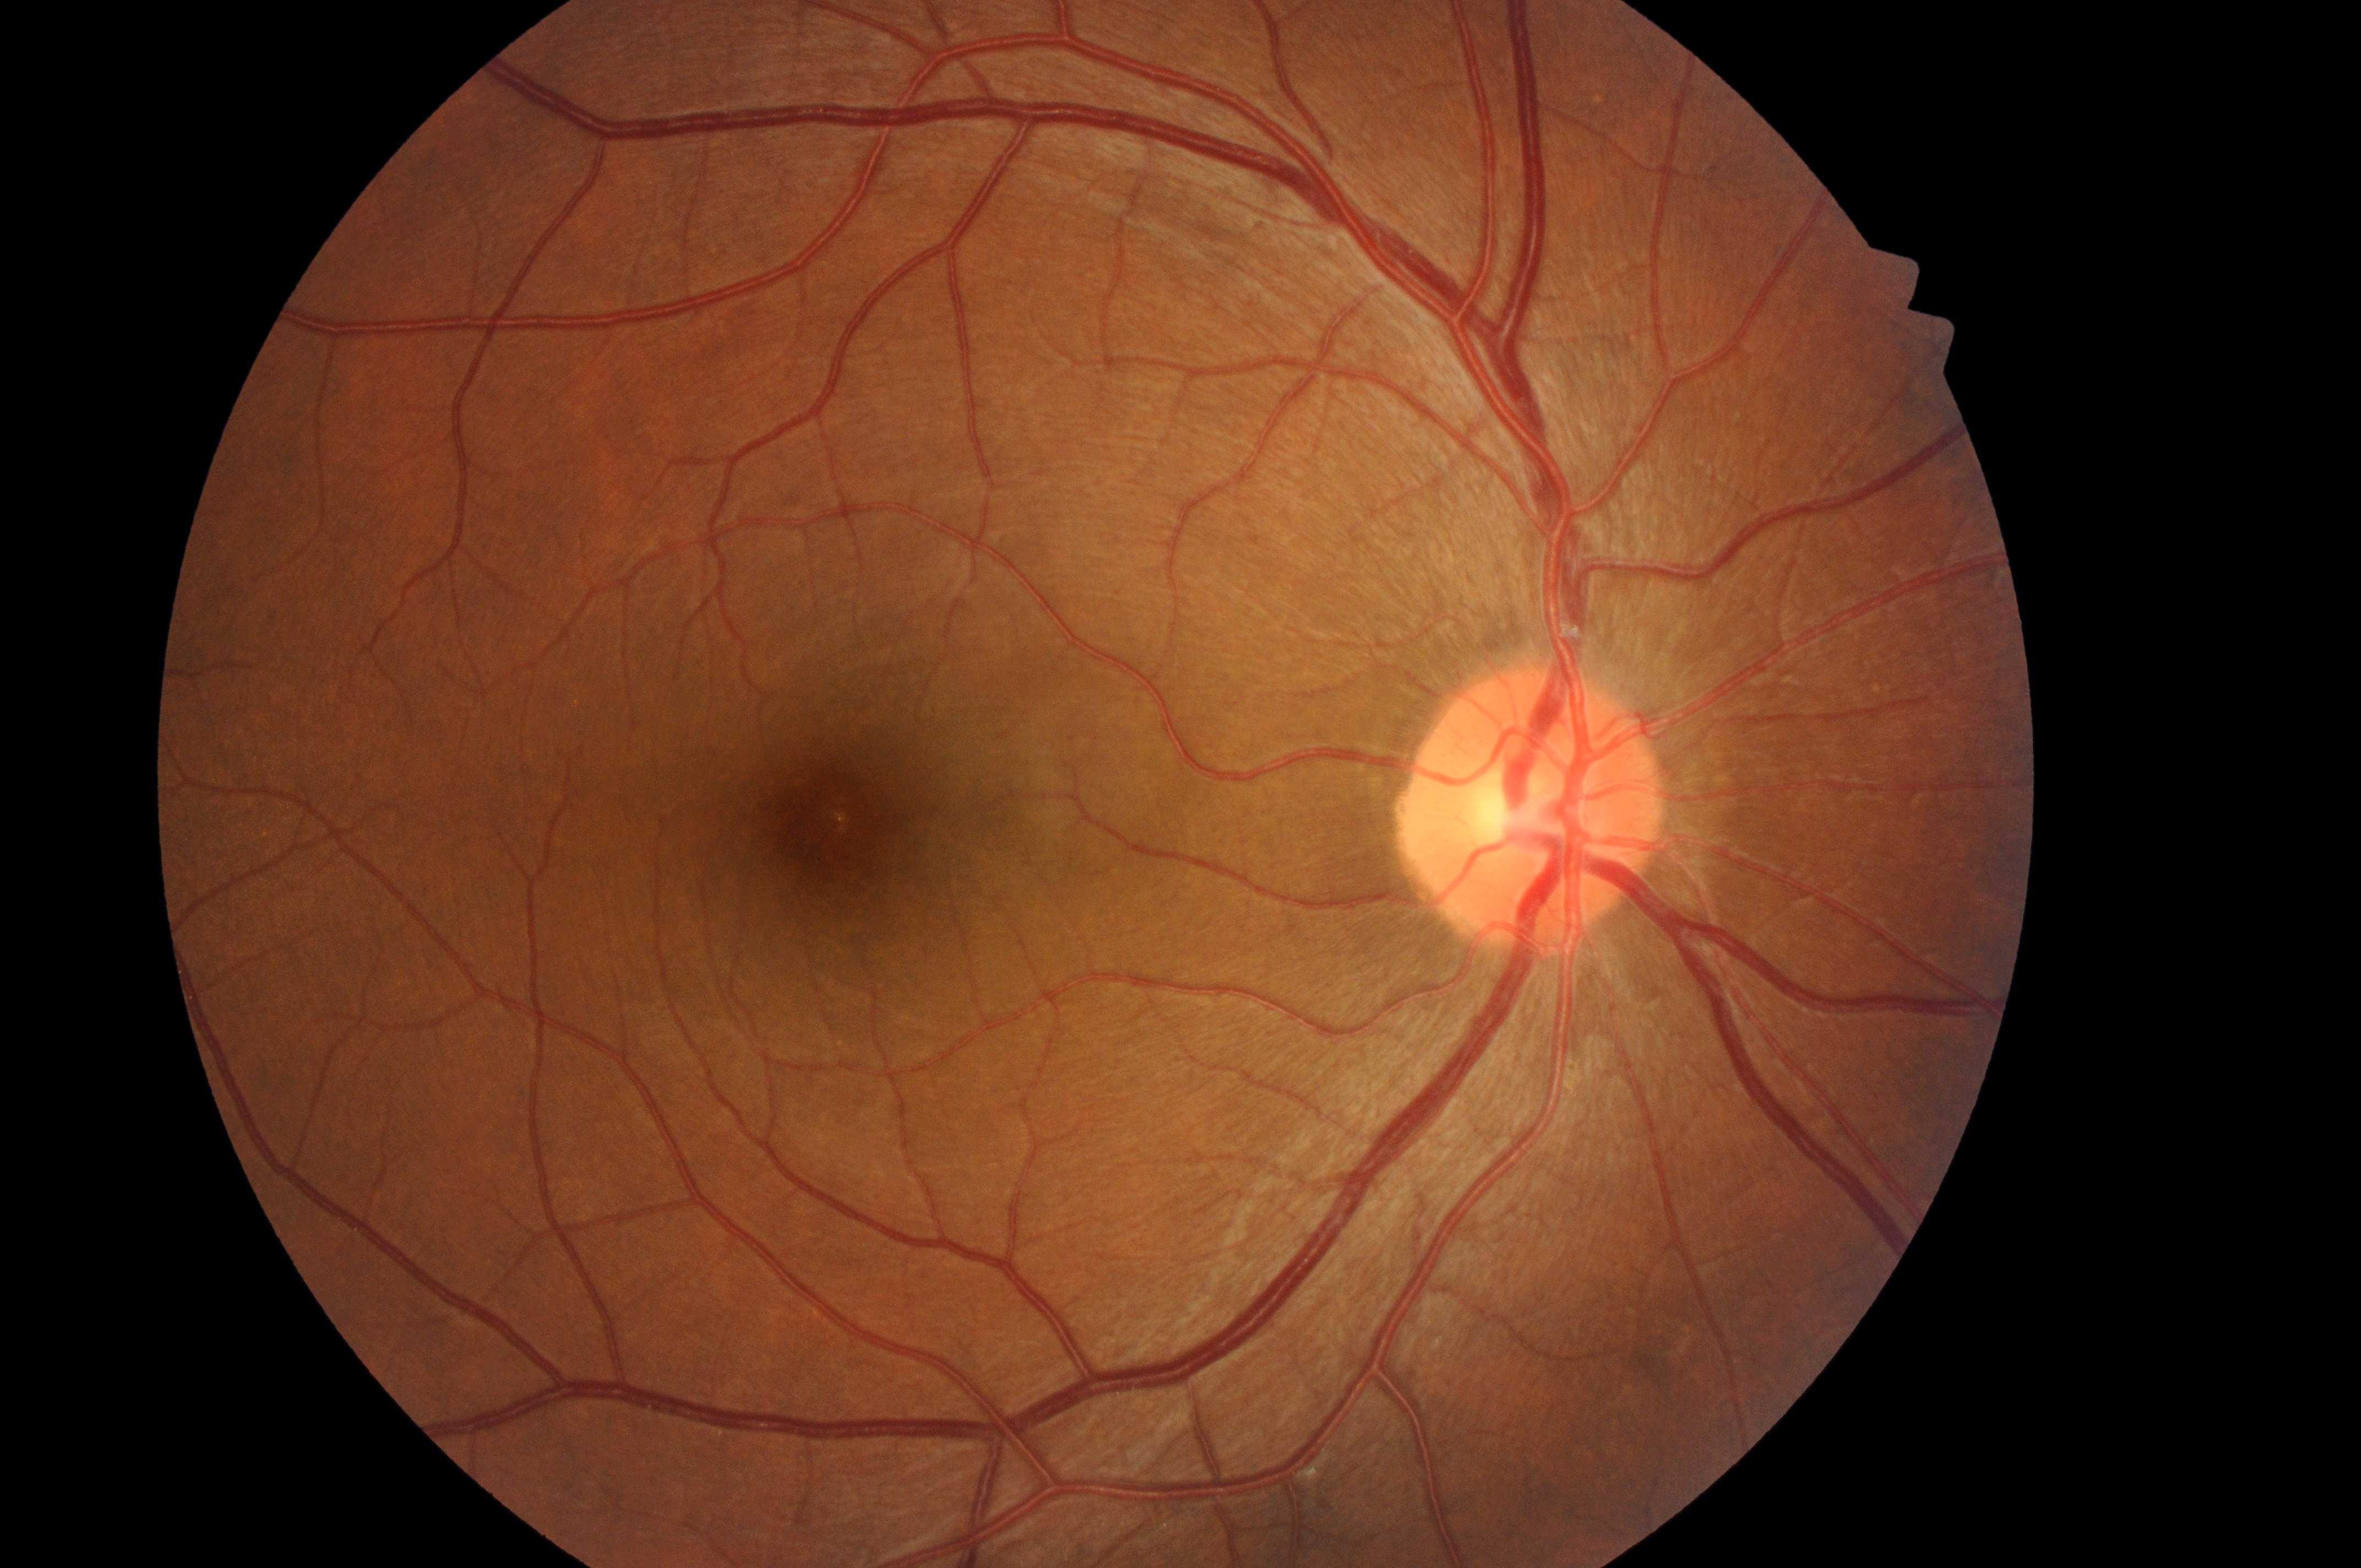

Optic disc: 1528, 814. Fovea centralis: 833, 826. Risk of diabetic macular edema: grade 0 (no risk). No signs of diabetic retinopathy or diabetic macular edema. Diabetic retinopathy is grade 0 (no apparent retinopathy). The image shows the oculus dexter.